2212x1659.
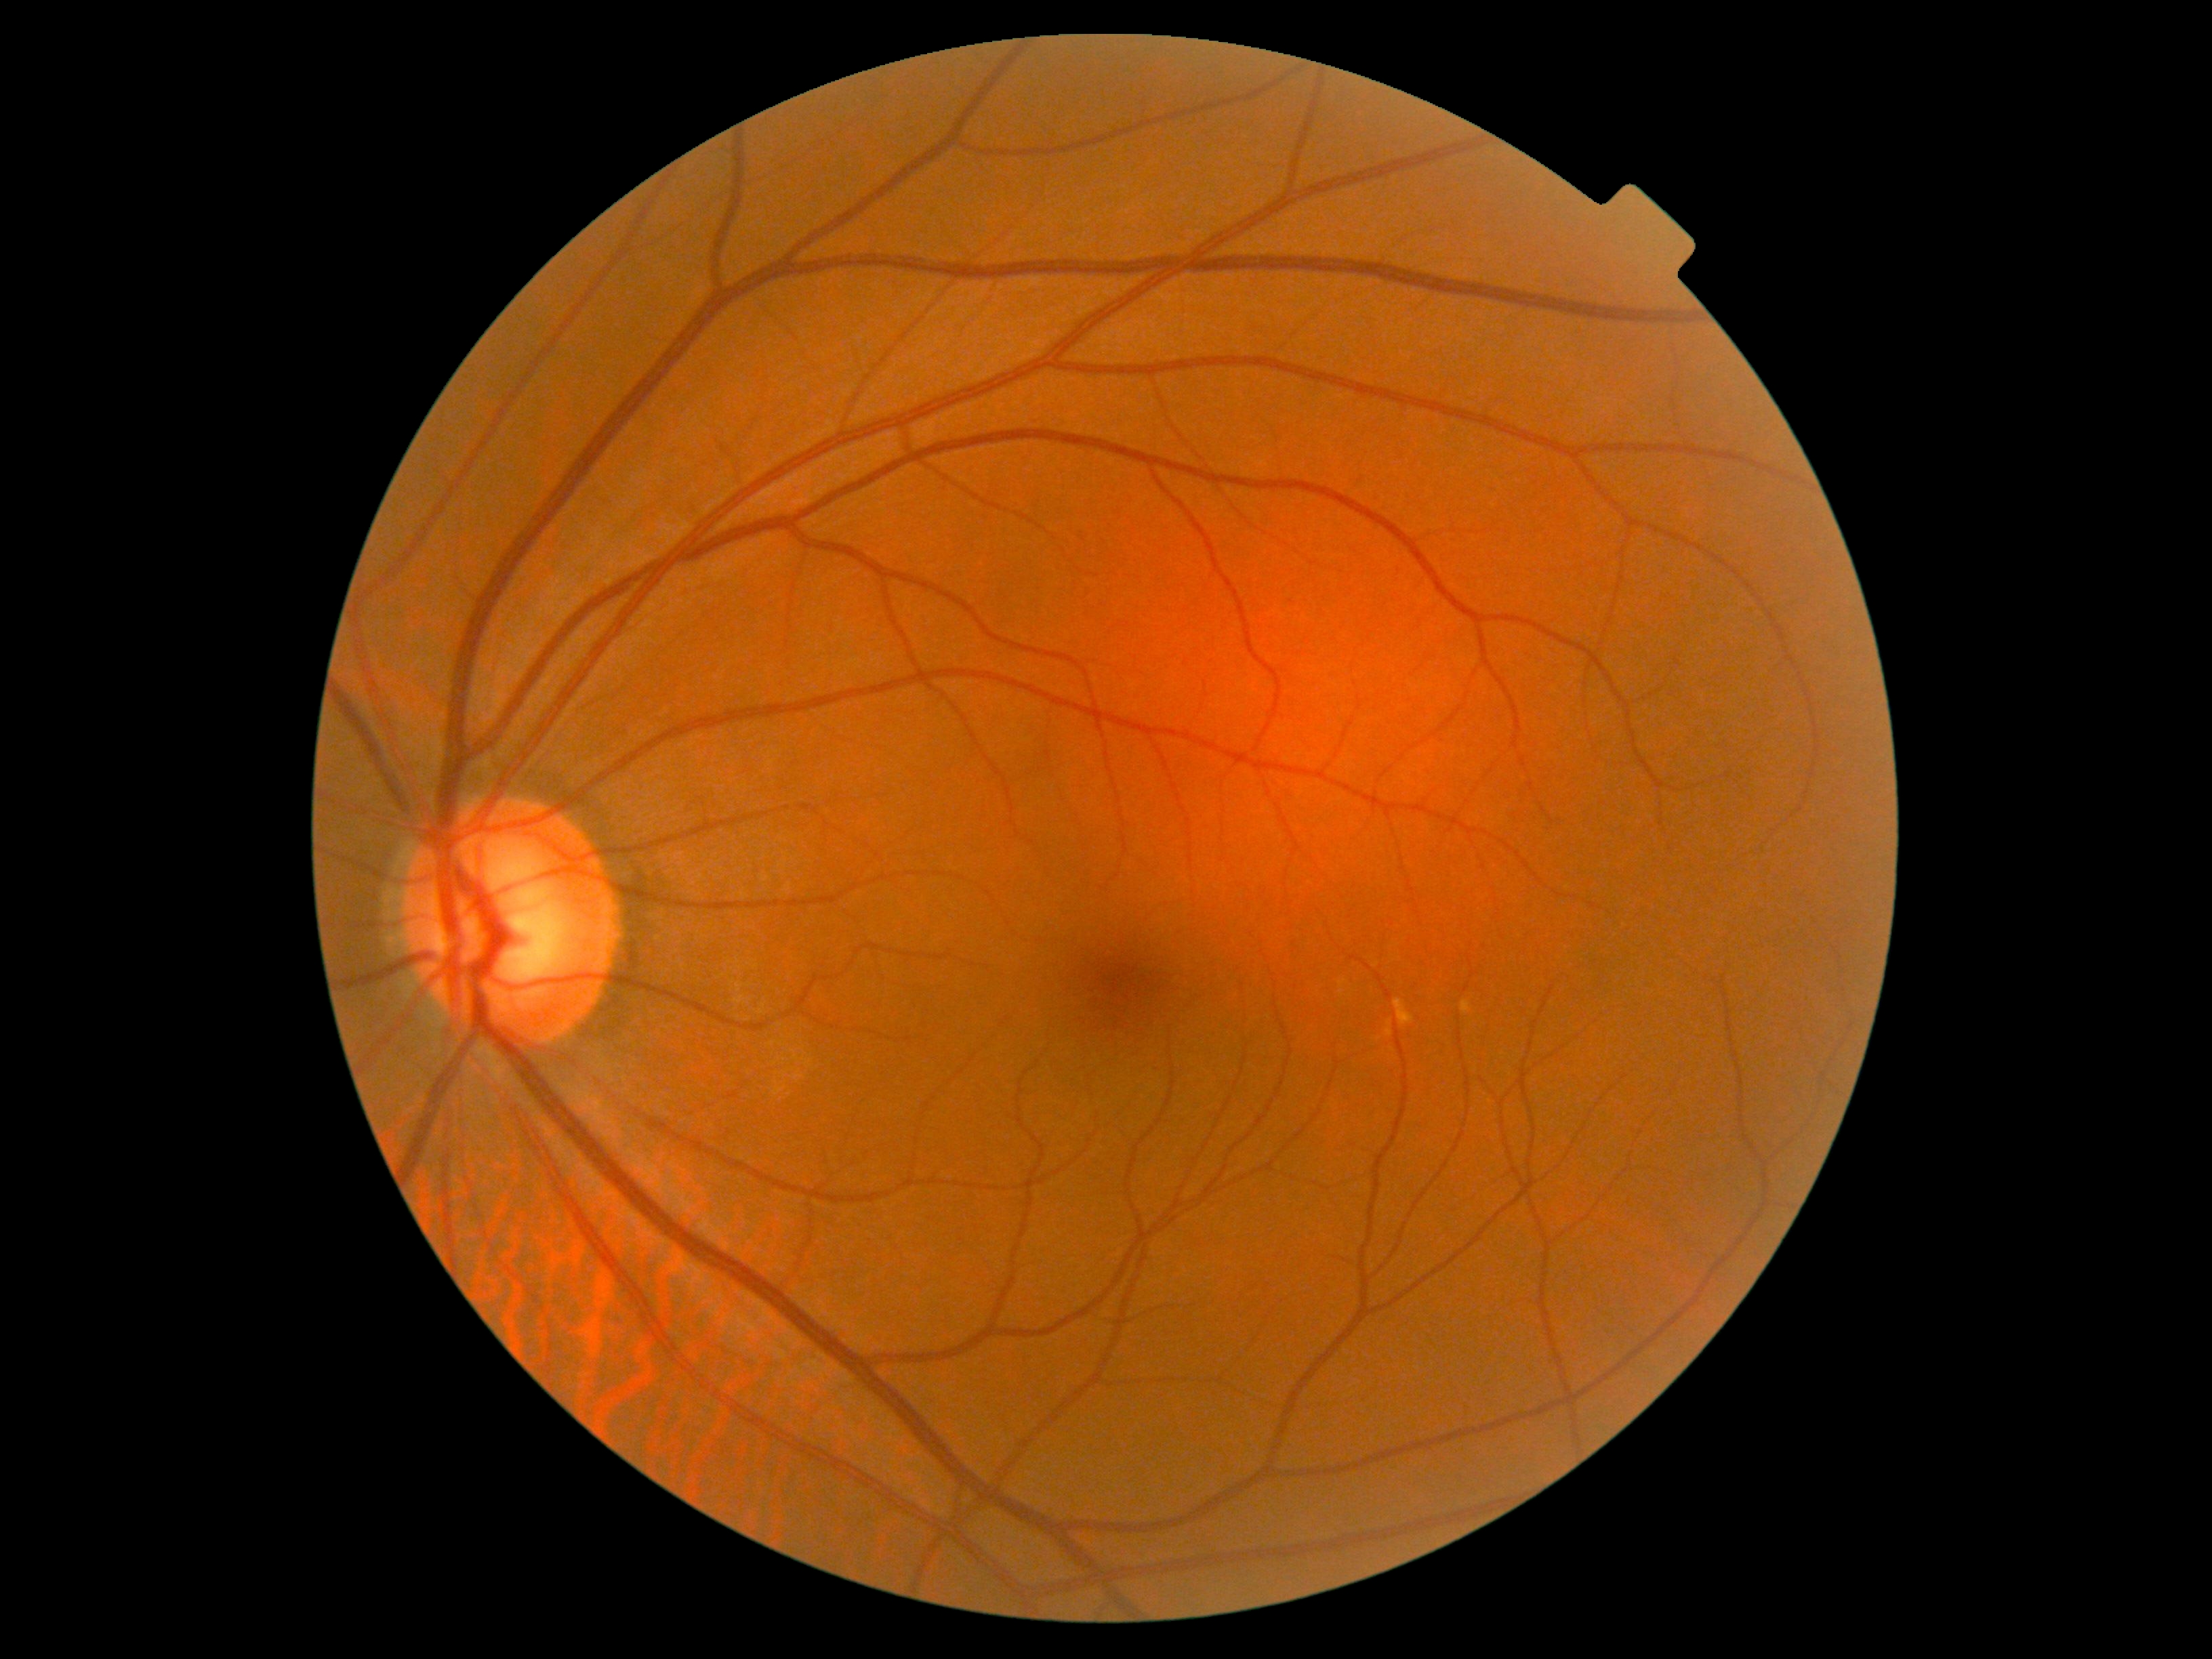

DR: grade 0 (no apparent retinopathy).